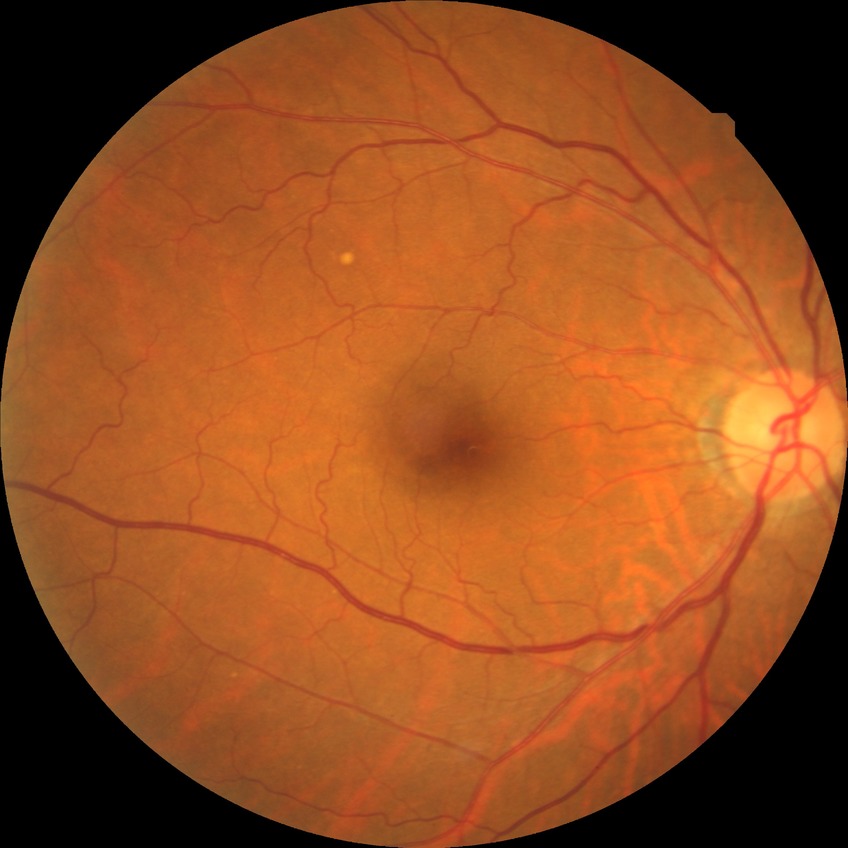

diabetic retinopathy (DR): NDR (no diabetic retinopathy).